Wide-field fundus photograph from neonatal ROP screening · 640 by 480 pixels — 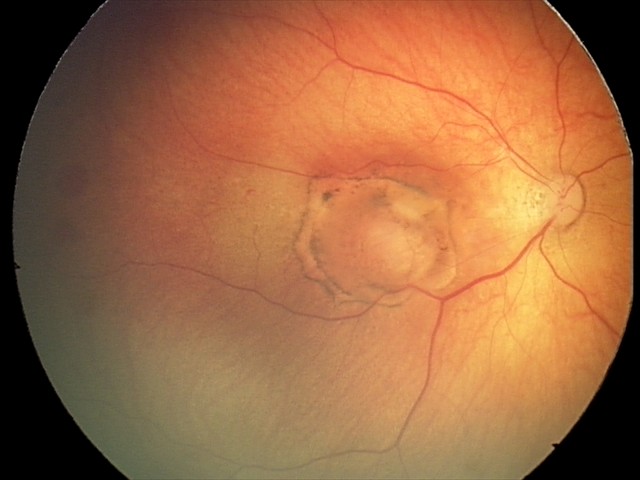

Diagnosis: toxoplasmosis chorioretinitis